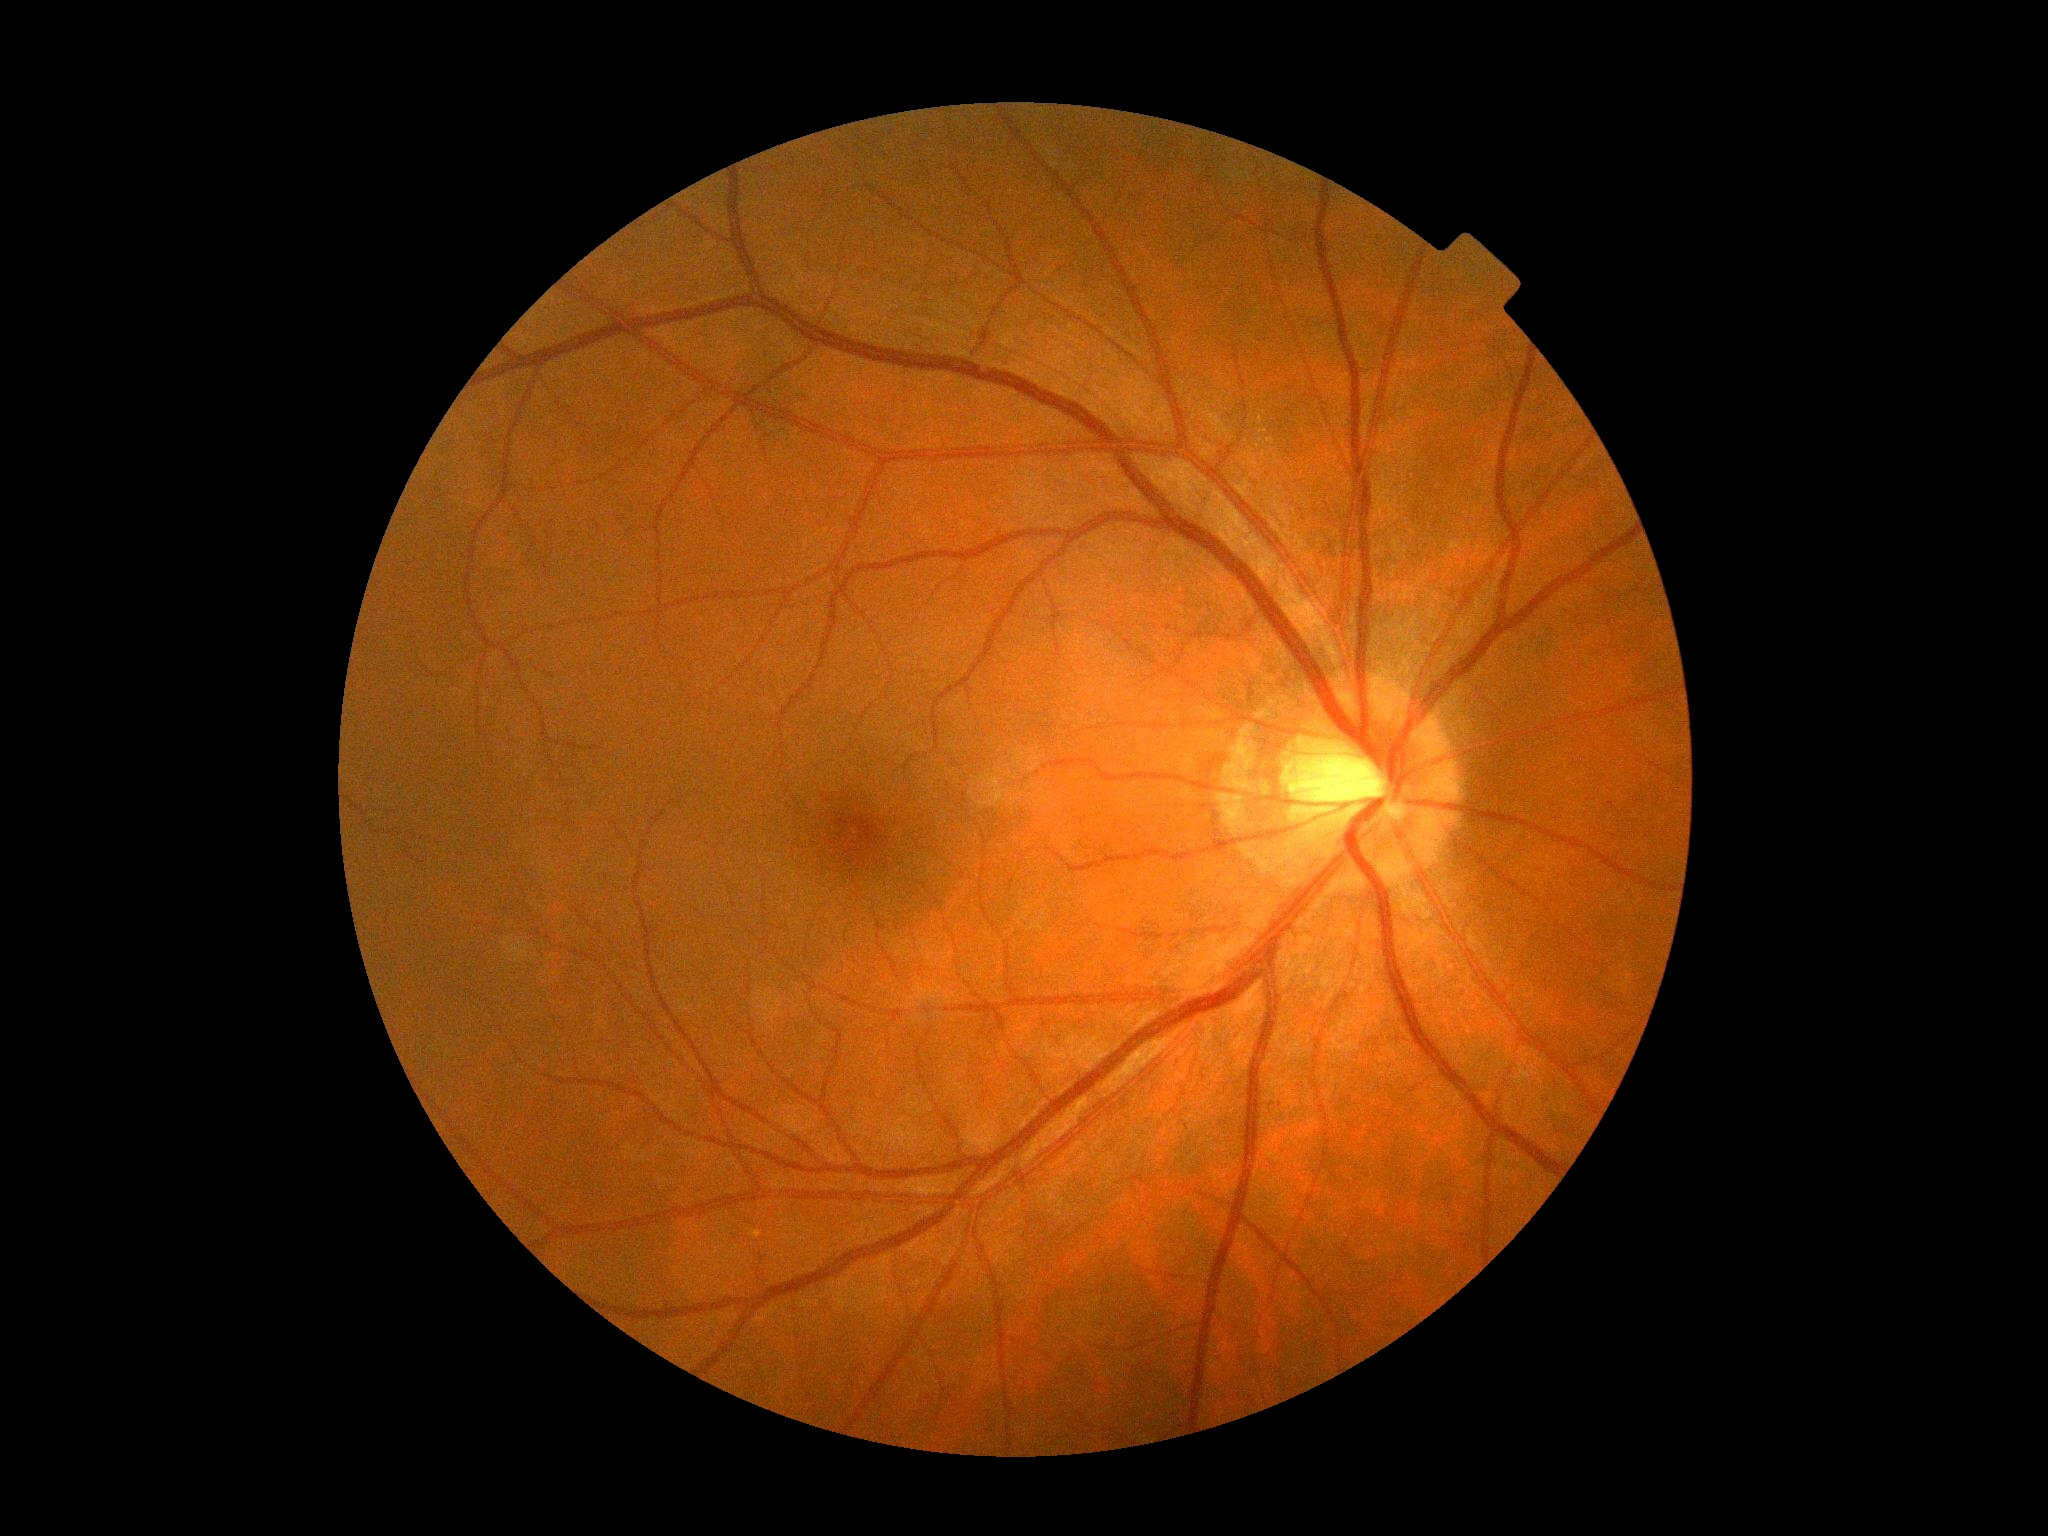
Retinopathy is no apparent diabetic retinopathy (grade 0) — no visible signs of diabetic retinopathy.
No apparent diabetic retinopathy.